NIDEK AFC-230 fundus camera. Modified Davis grading
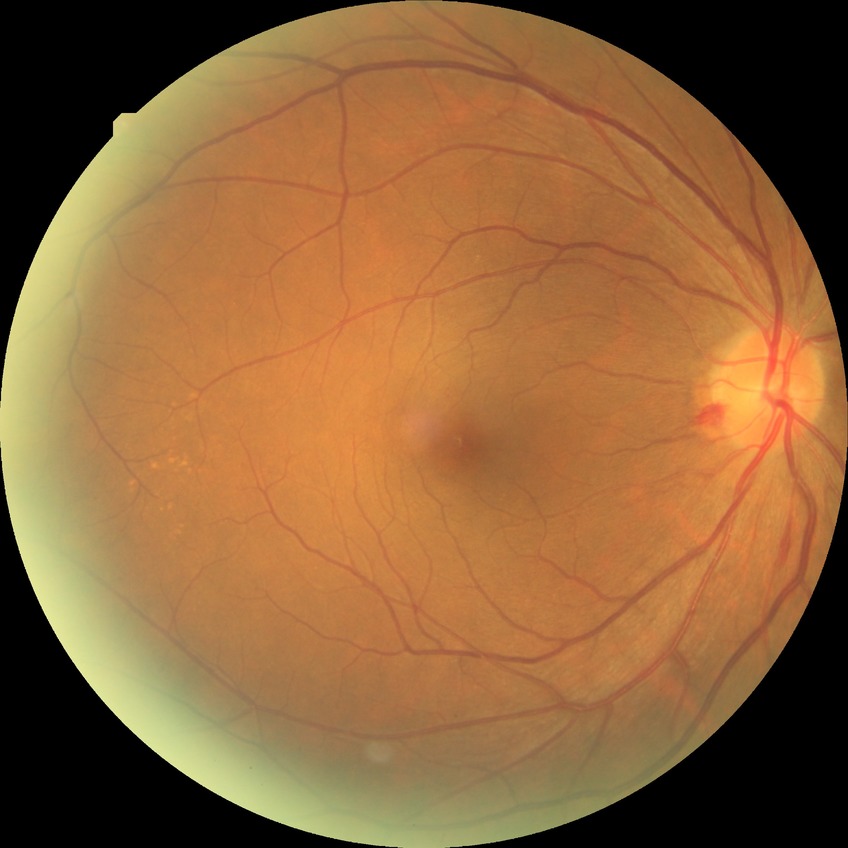 Retinopathy stage is simple diabetic retinopathy. Disease class: non-proliferative diabetic retinopathy.